Captured with the Phoenix ICON (100° field of view). Phoenix ICON wide-field infant fundus image:
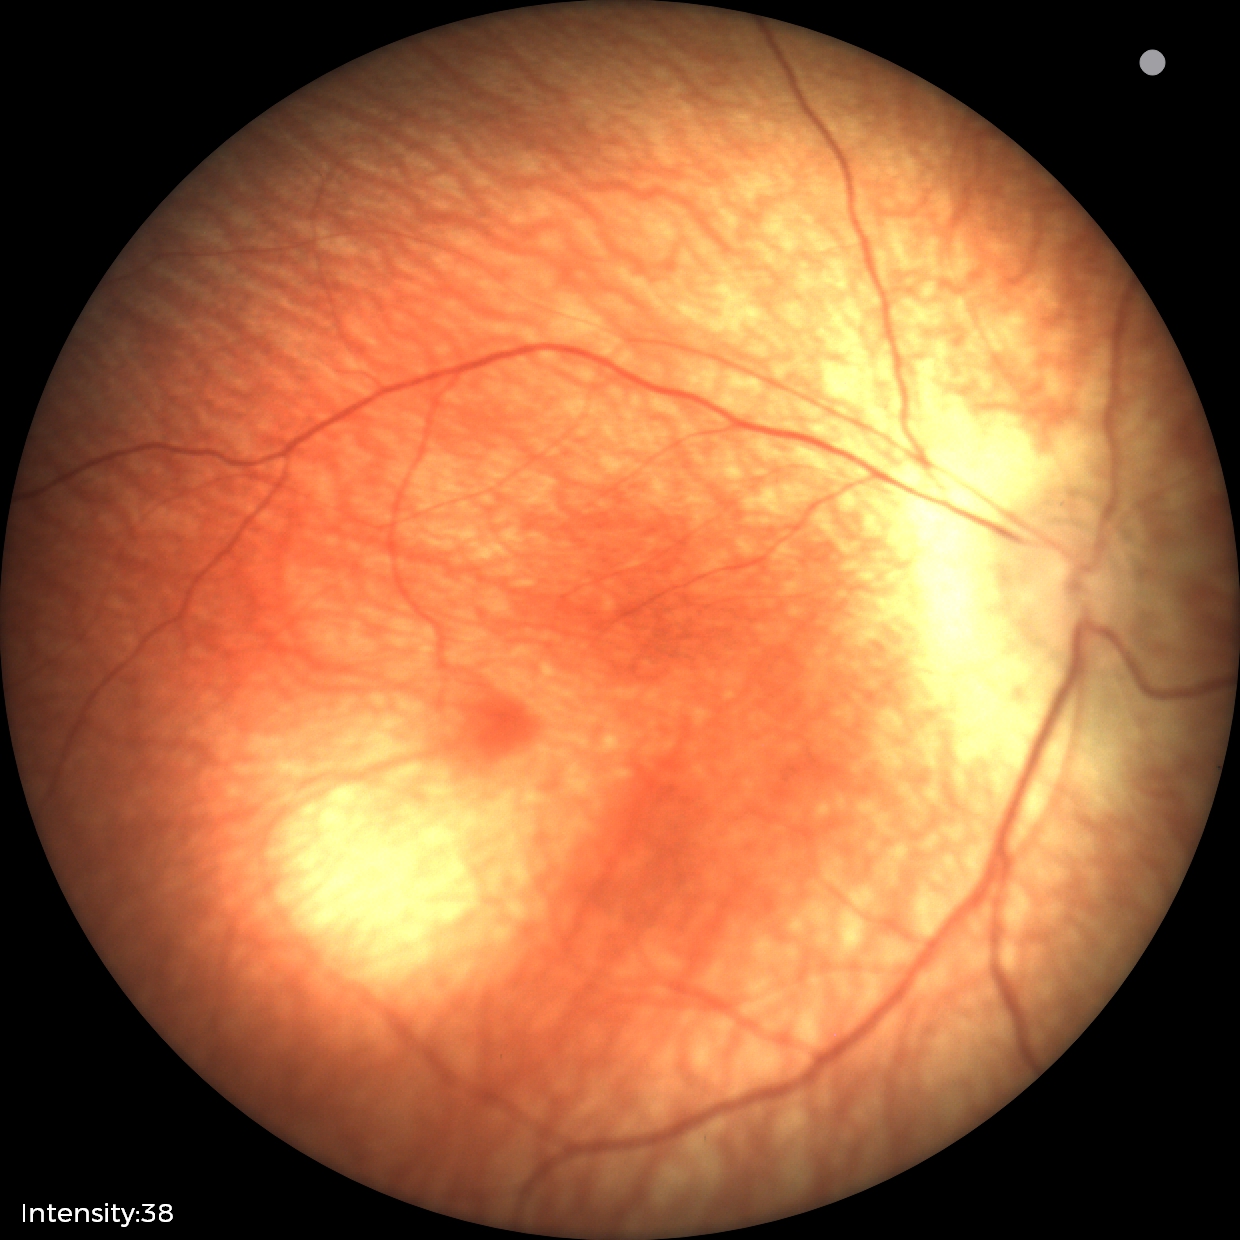

Normal screening examination.